Modified Davis classification
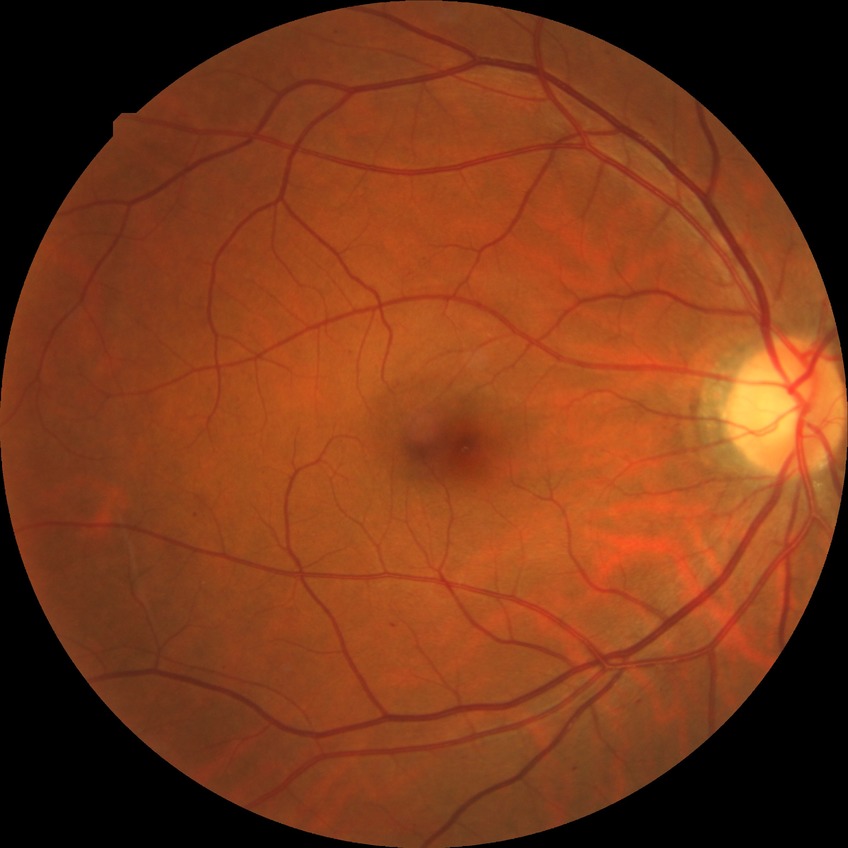 diabetic retinopathy (DR) = SDR (simple diabetic retinopathy).